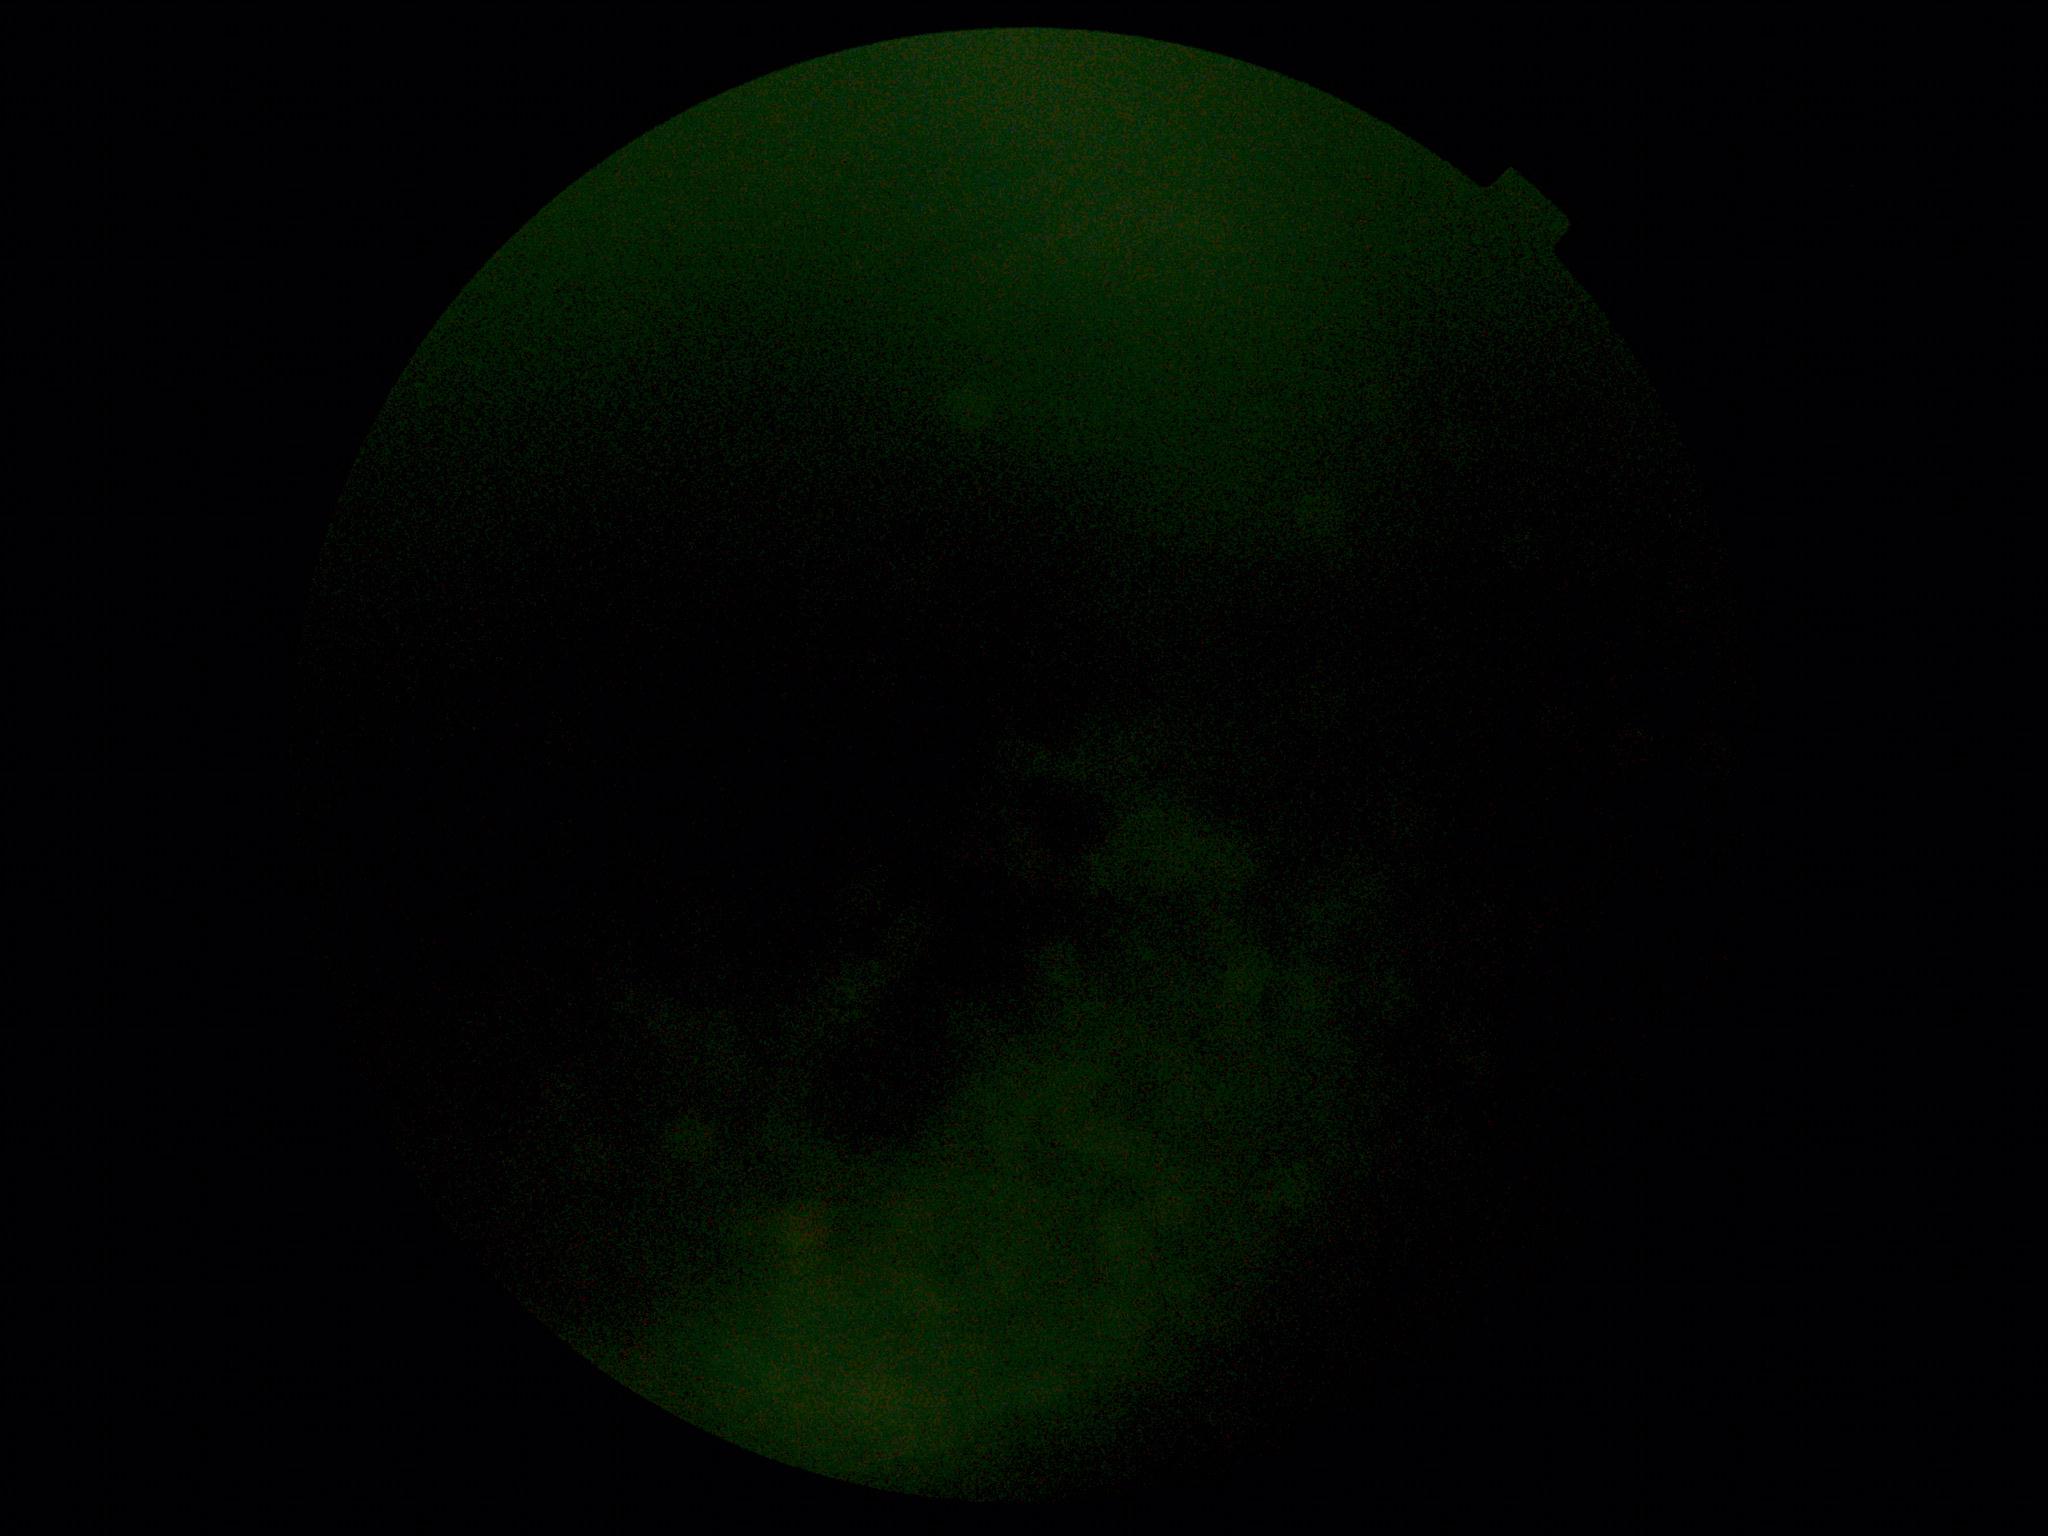

Ungradable image — DR severity cannot be determined. Diabetic retinopathy severity is ungradable due to poor image quality.